Cropped to the optic nerve head, fundus photo: 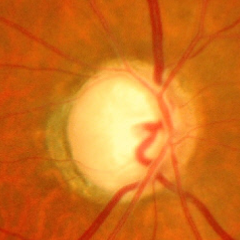

There is evidence of advanced glaucomatous optic neuropathy. Diagnostic criteria: near-total cupping of the optic nerve head, with or without severe visual field loss within the central 10 degrees of fixation.